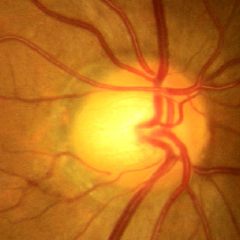 Q: What stage of glaucoma is present?
A: No glaucoma.